Fundus photo. 1536 by 1152 pixels — 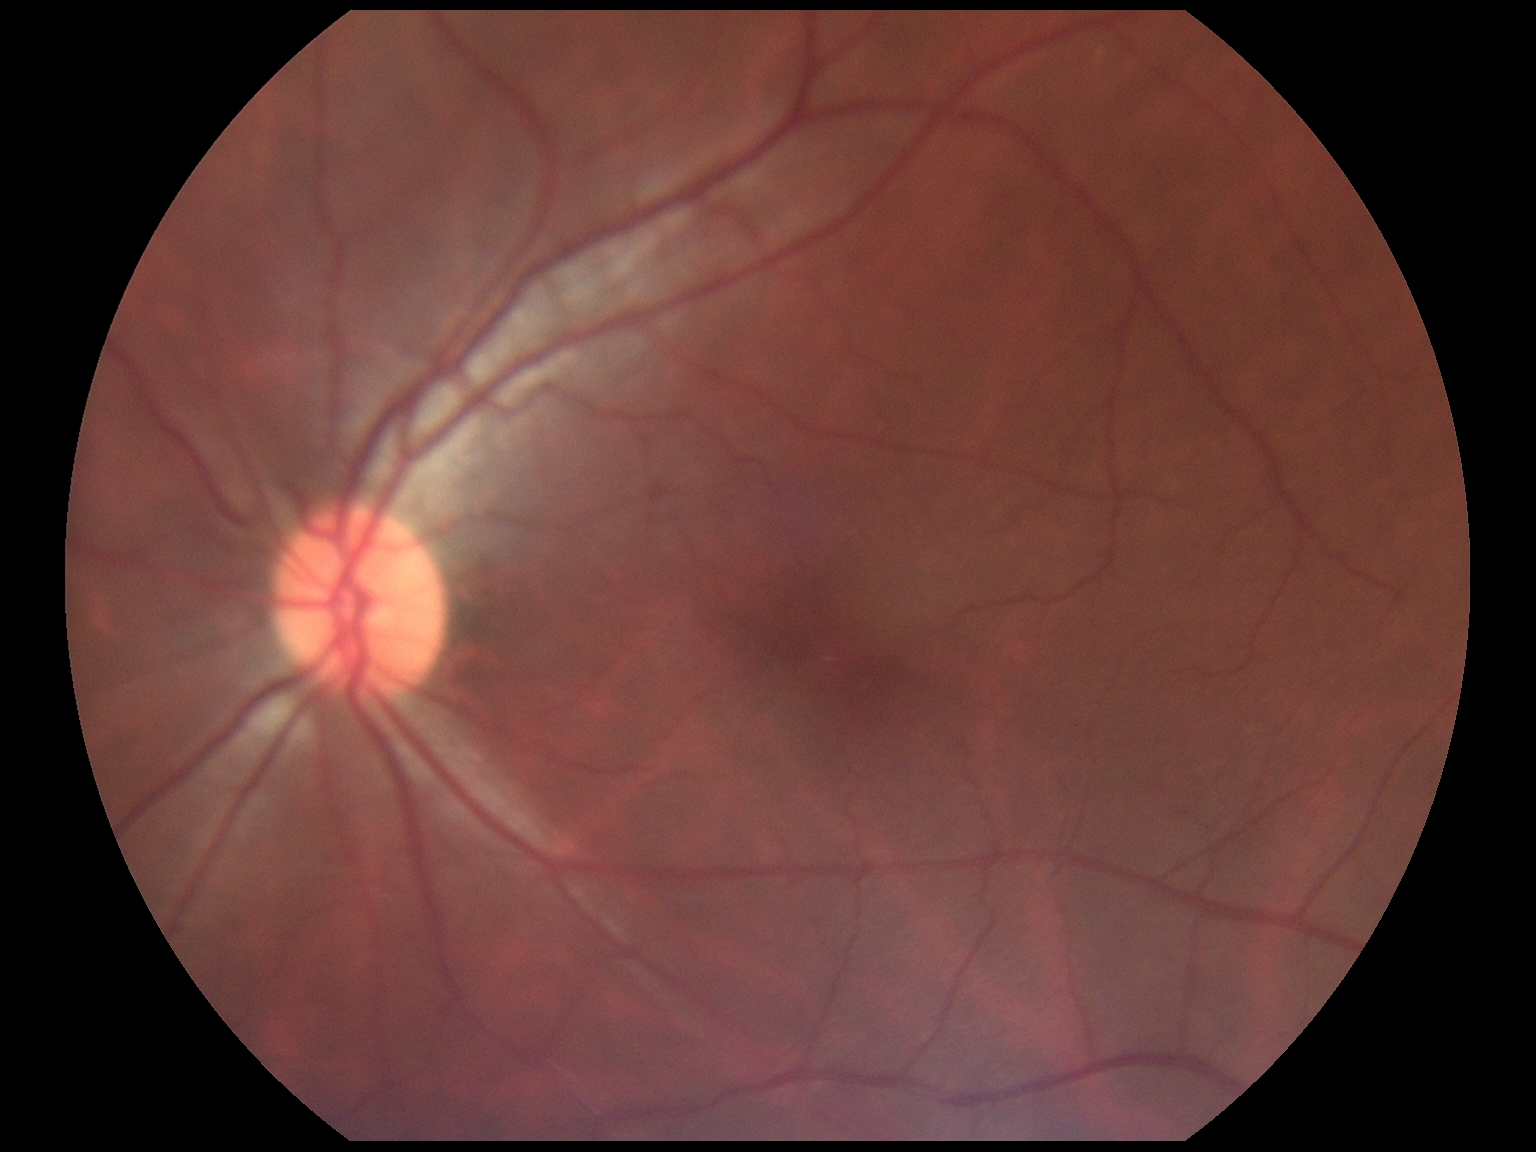

DR stage is grade 0.